1240x1240. Phoenix ICON, 100° FOV. Phoenix ICON wide-field infant fundus image: 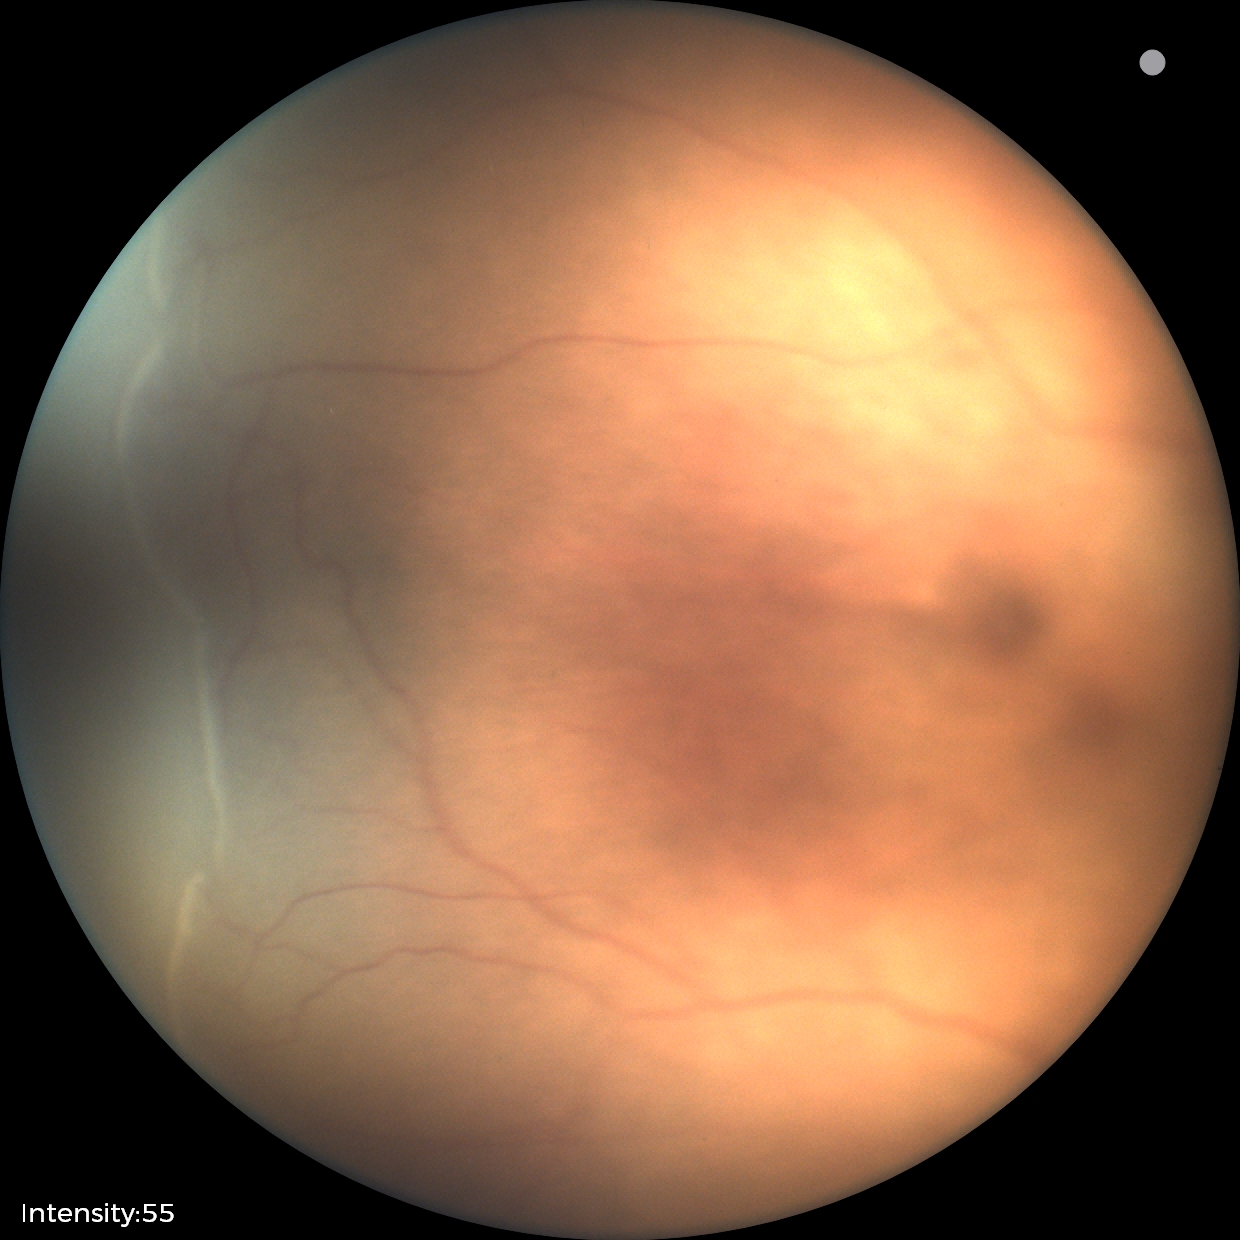

Screening examination consistent with ROP stage 2. Without plus disease.